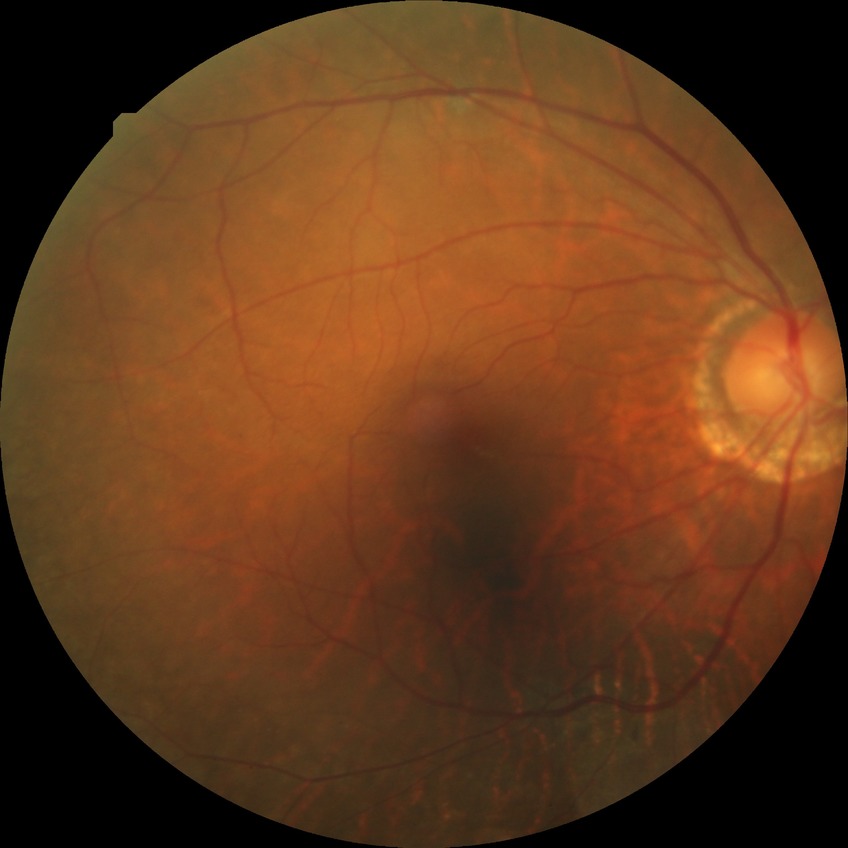

Davis grading is no diabetic retinopathy.